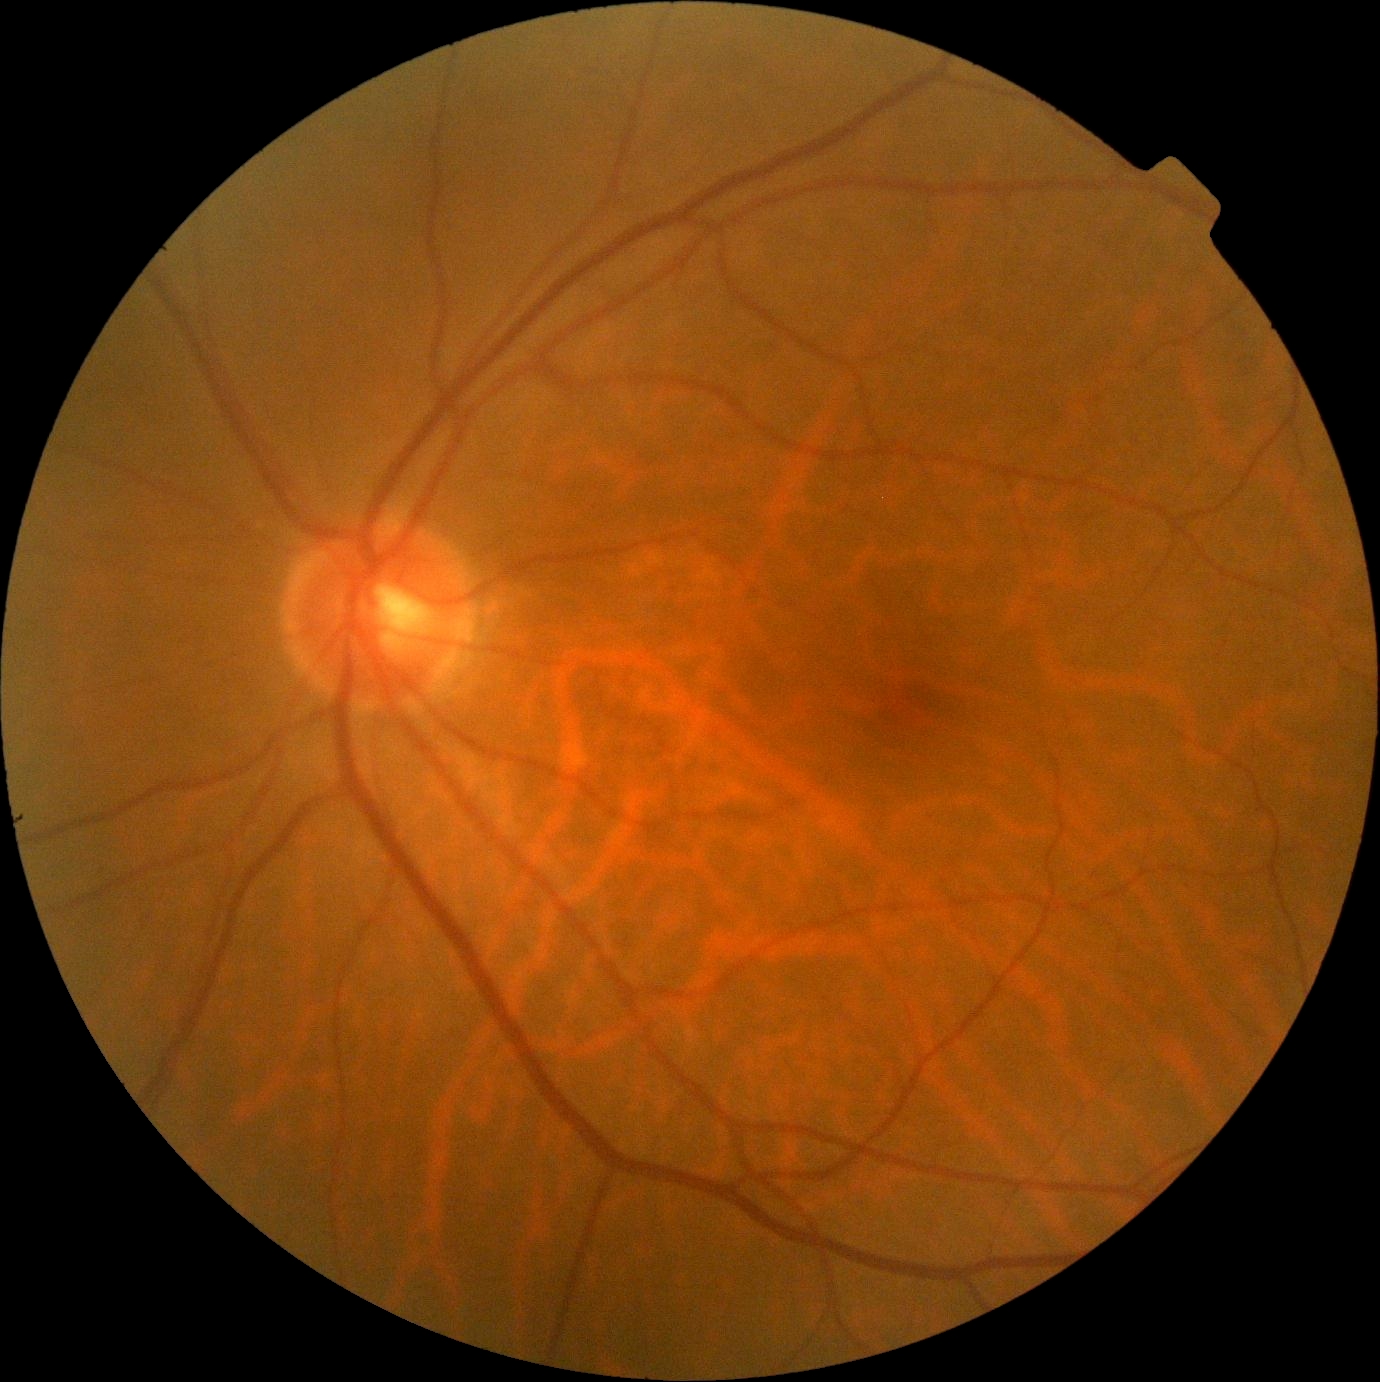
diabetic retinopathy (DR) = grade 0 (no apparent retinopathy) | DR impression = no signs of DR.